CFP; 45° field of view.
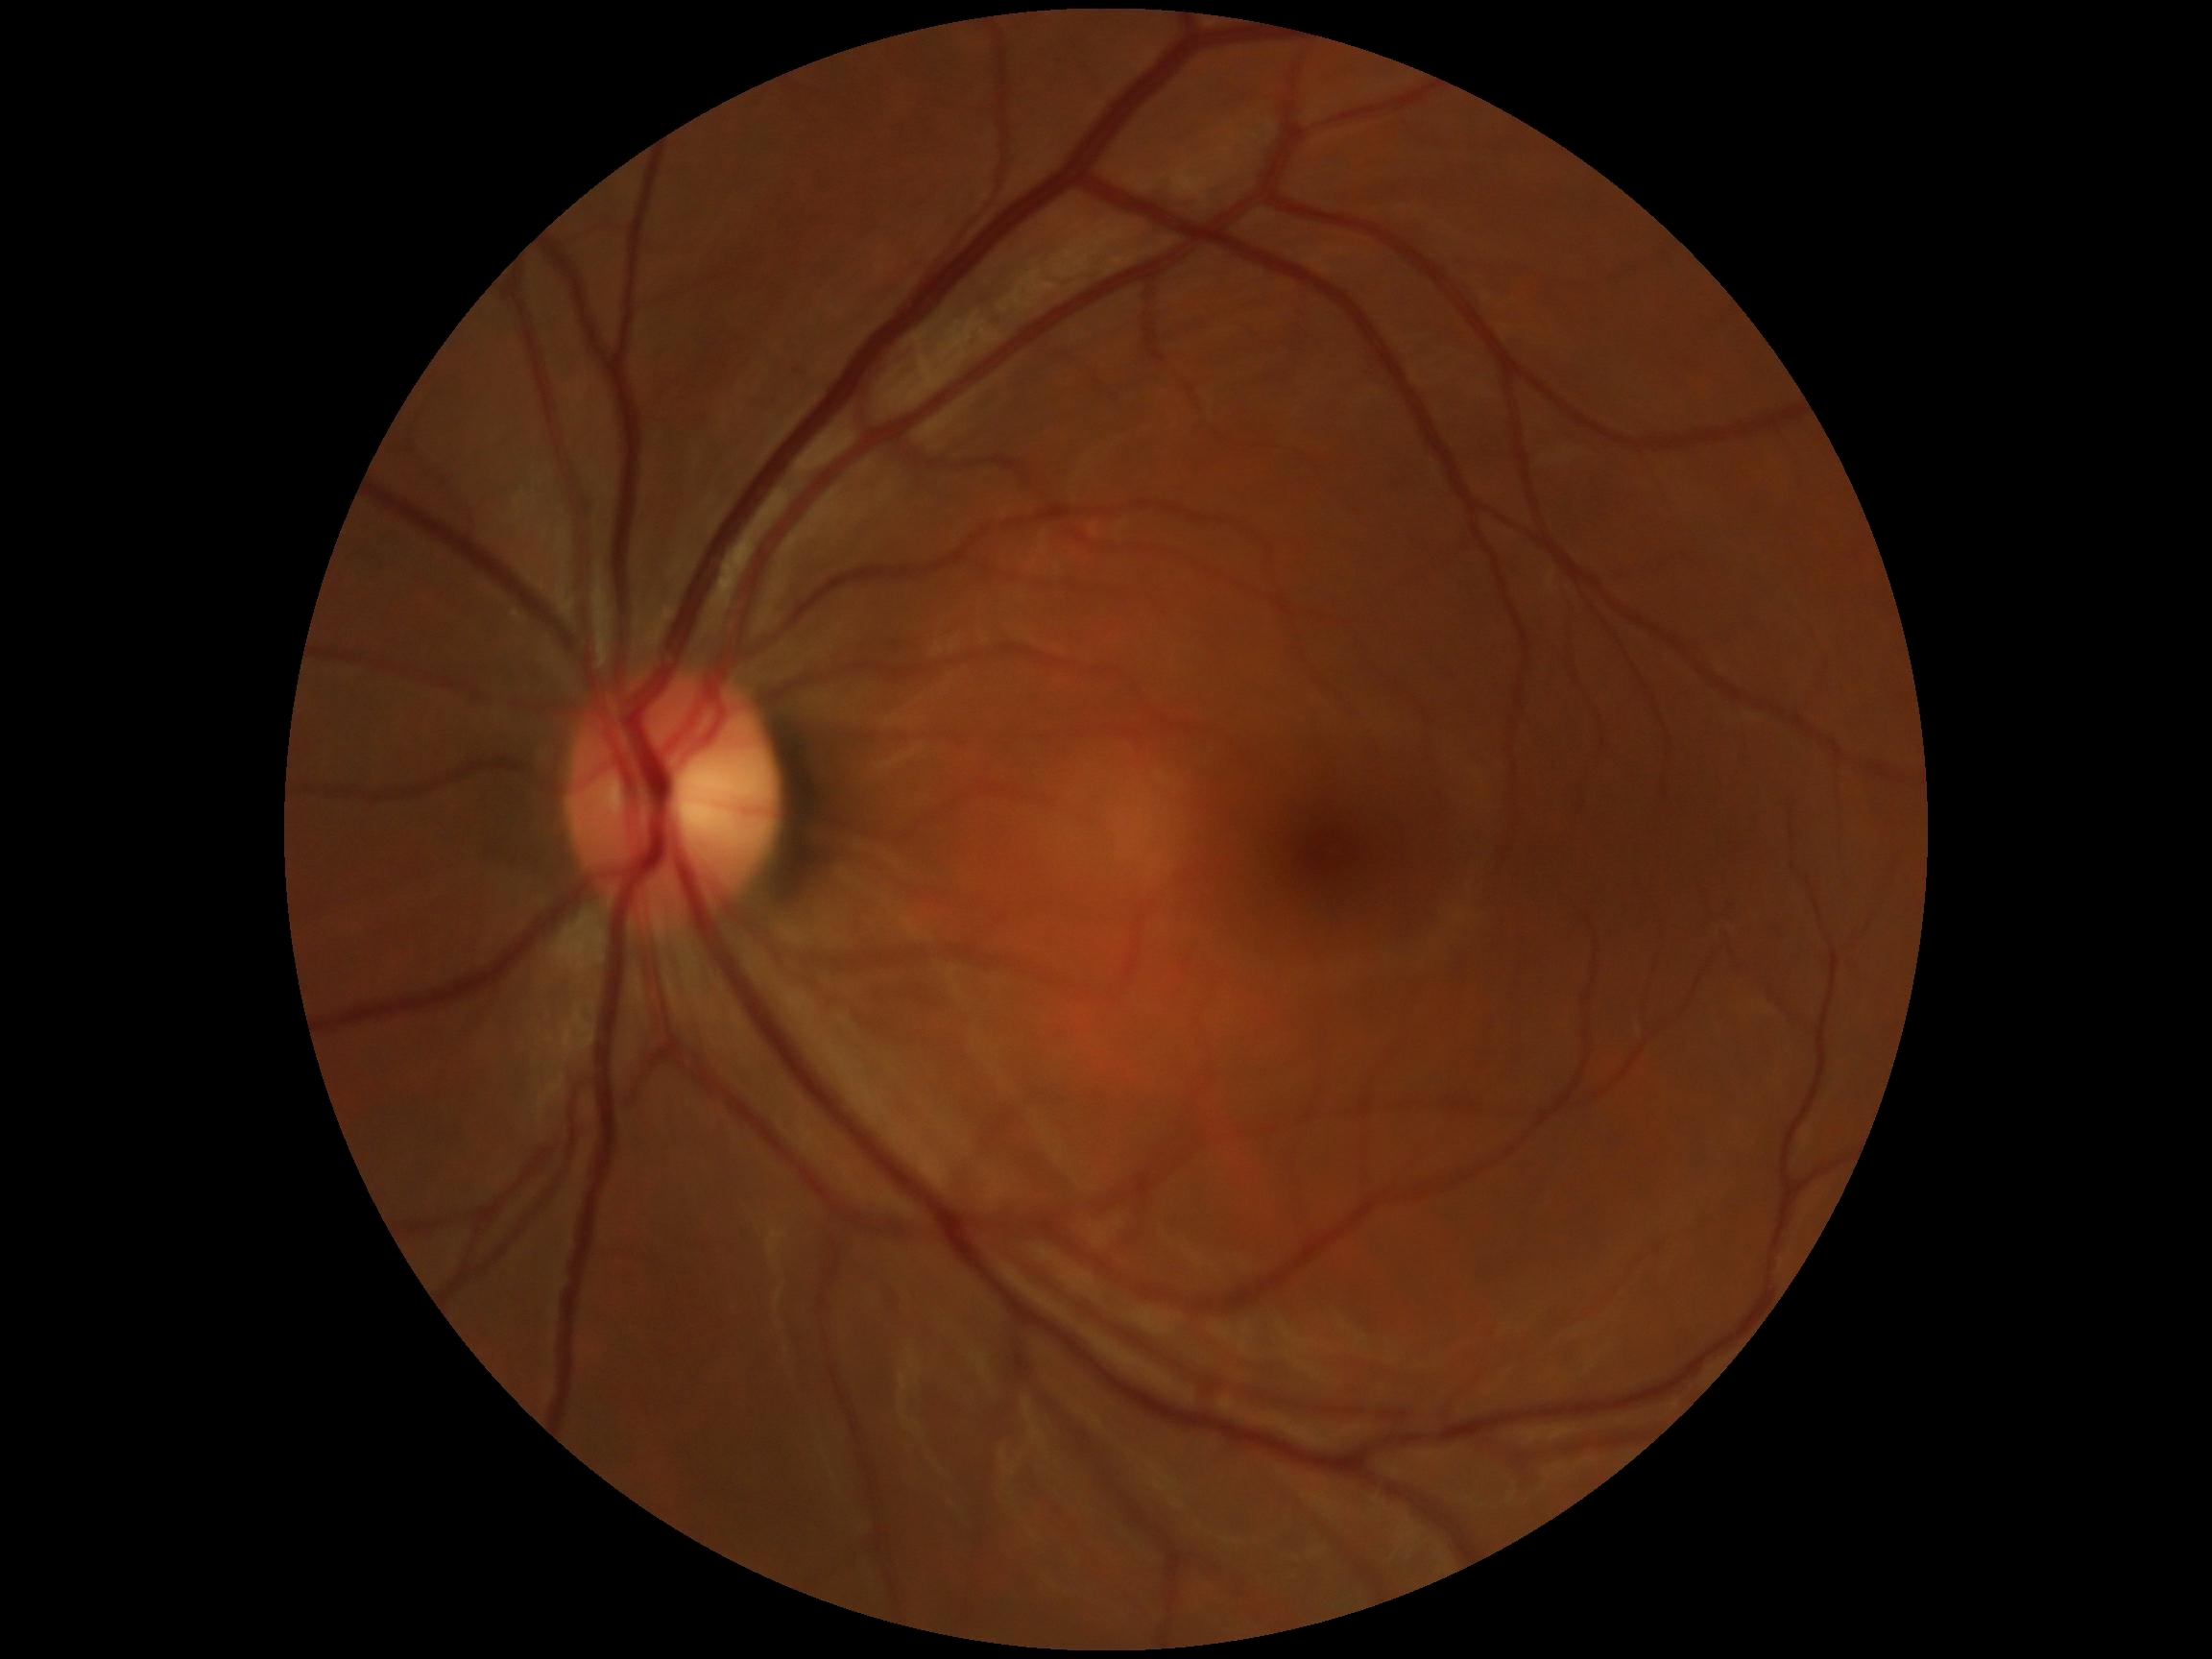

DR severity is 0.
No diabetic retinal disease findings.